45° field of view · NIDEK AFC-230 · 848x848 · without pupil dilation — 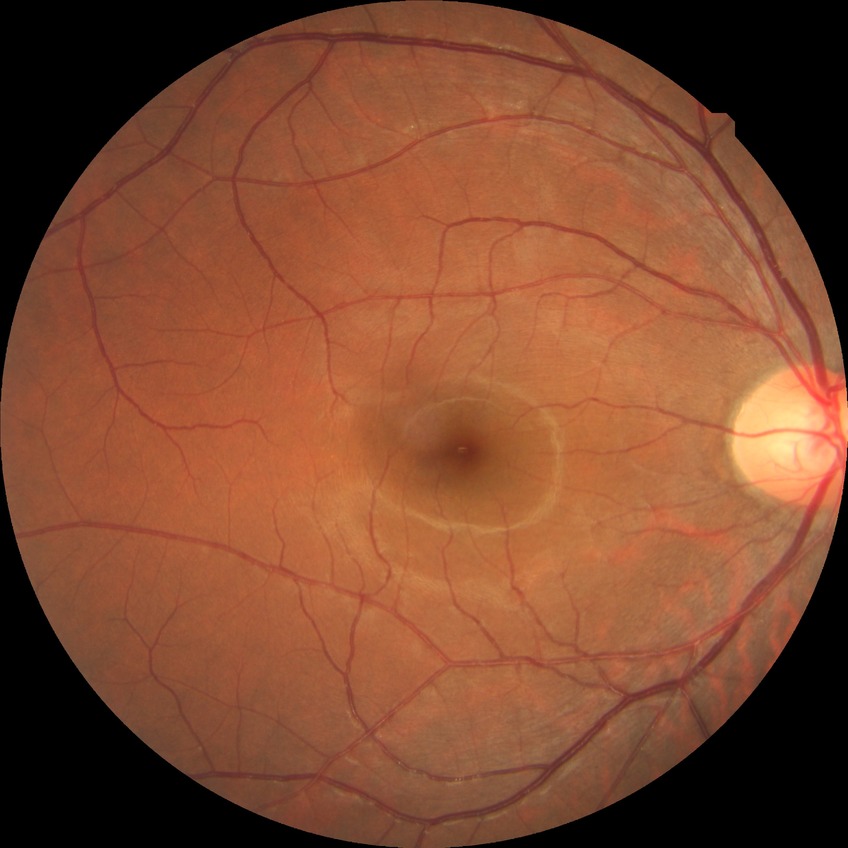

diabetic retinopathy (DR) = no diabetic retinopathy (NDR).